Corneal thickness: 562 µm. Refractive error: +0.5 -0.75 x 110. Patient age: 78 years.
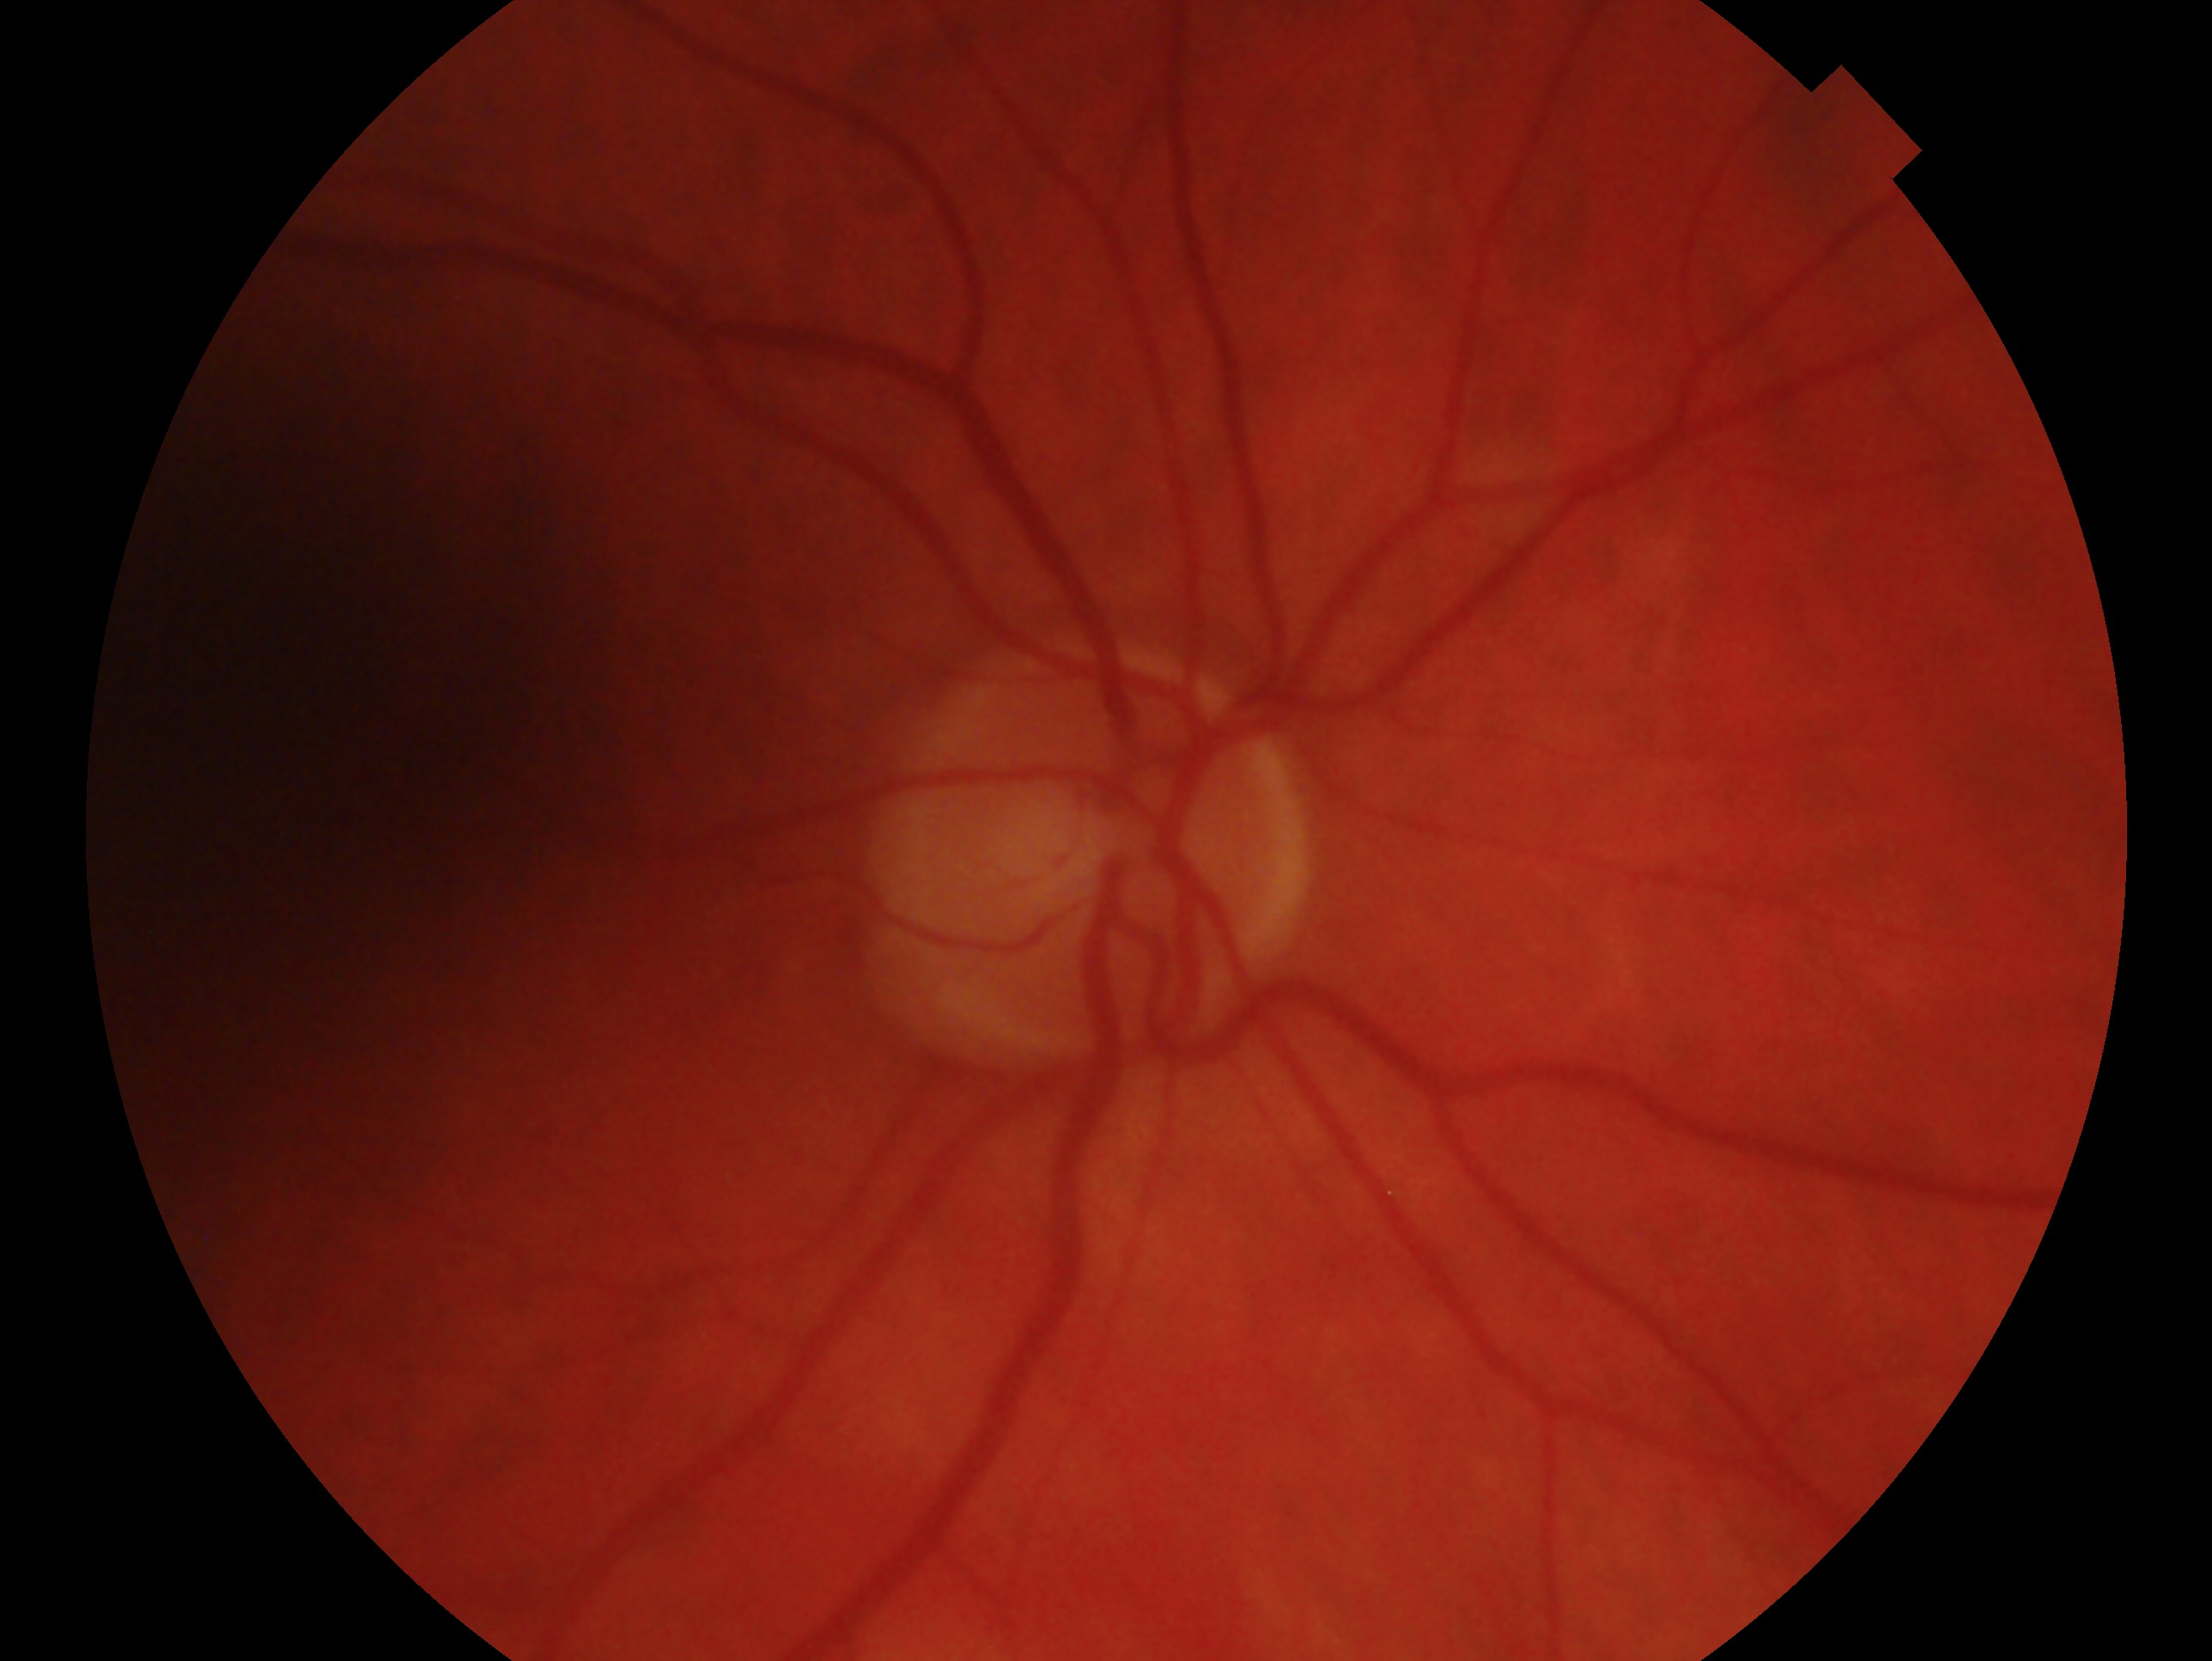 The image shows the right eye.
Glaucoma diagnosis: glaucomatous — clinically confirmed glaucoma with characteristic optic nerve damage.